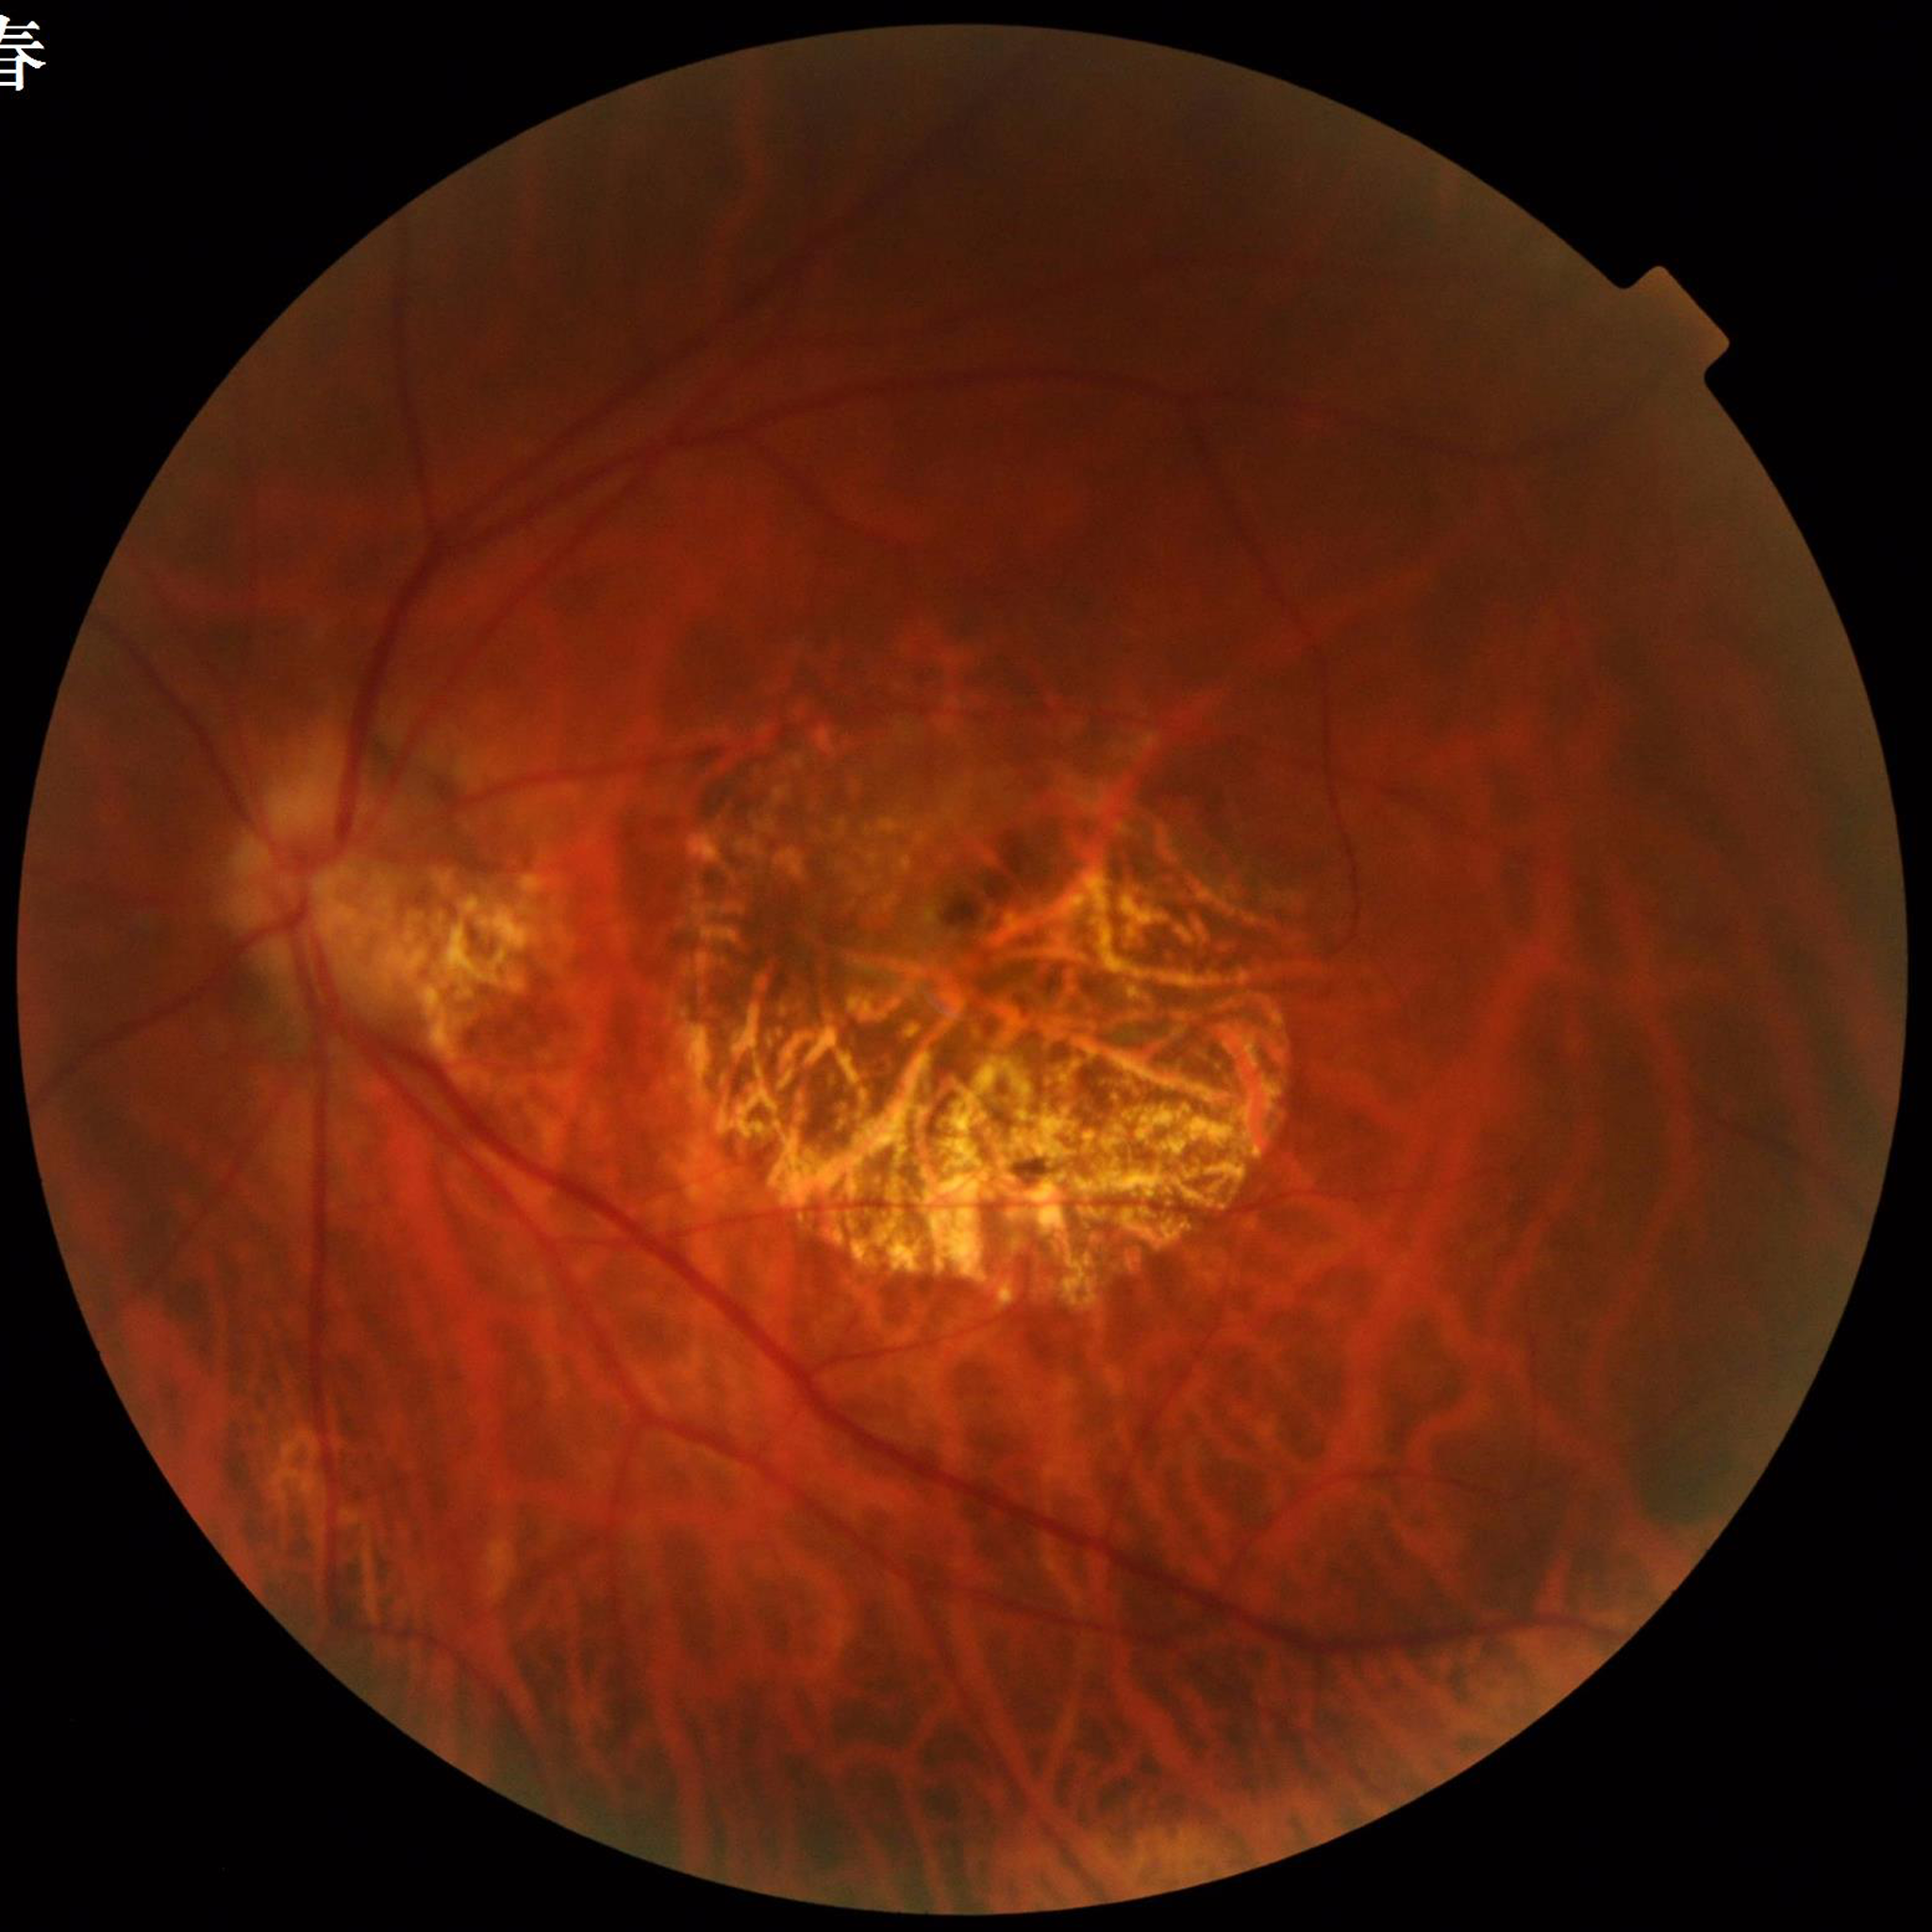
Quality: no quality issues identified | Disease class: age-related macular degeneration (AMD).